45-degree field of view: 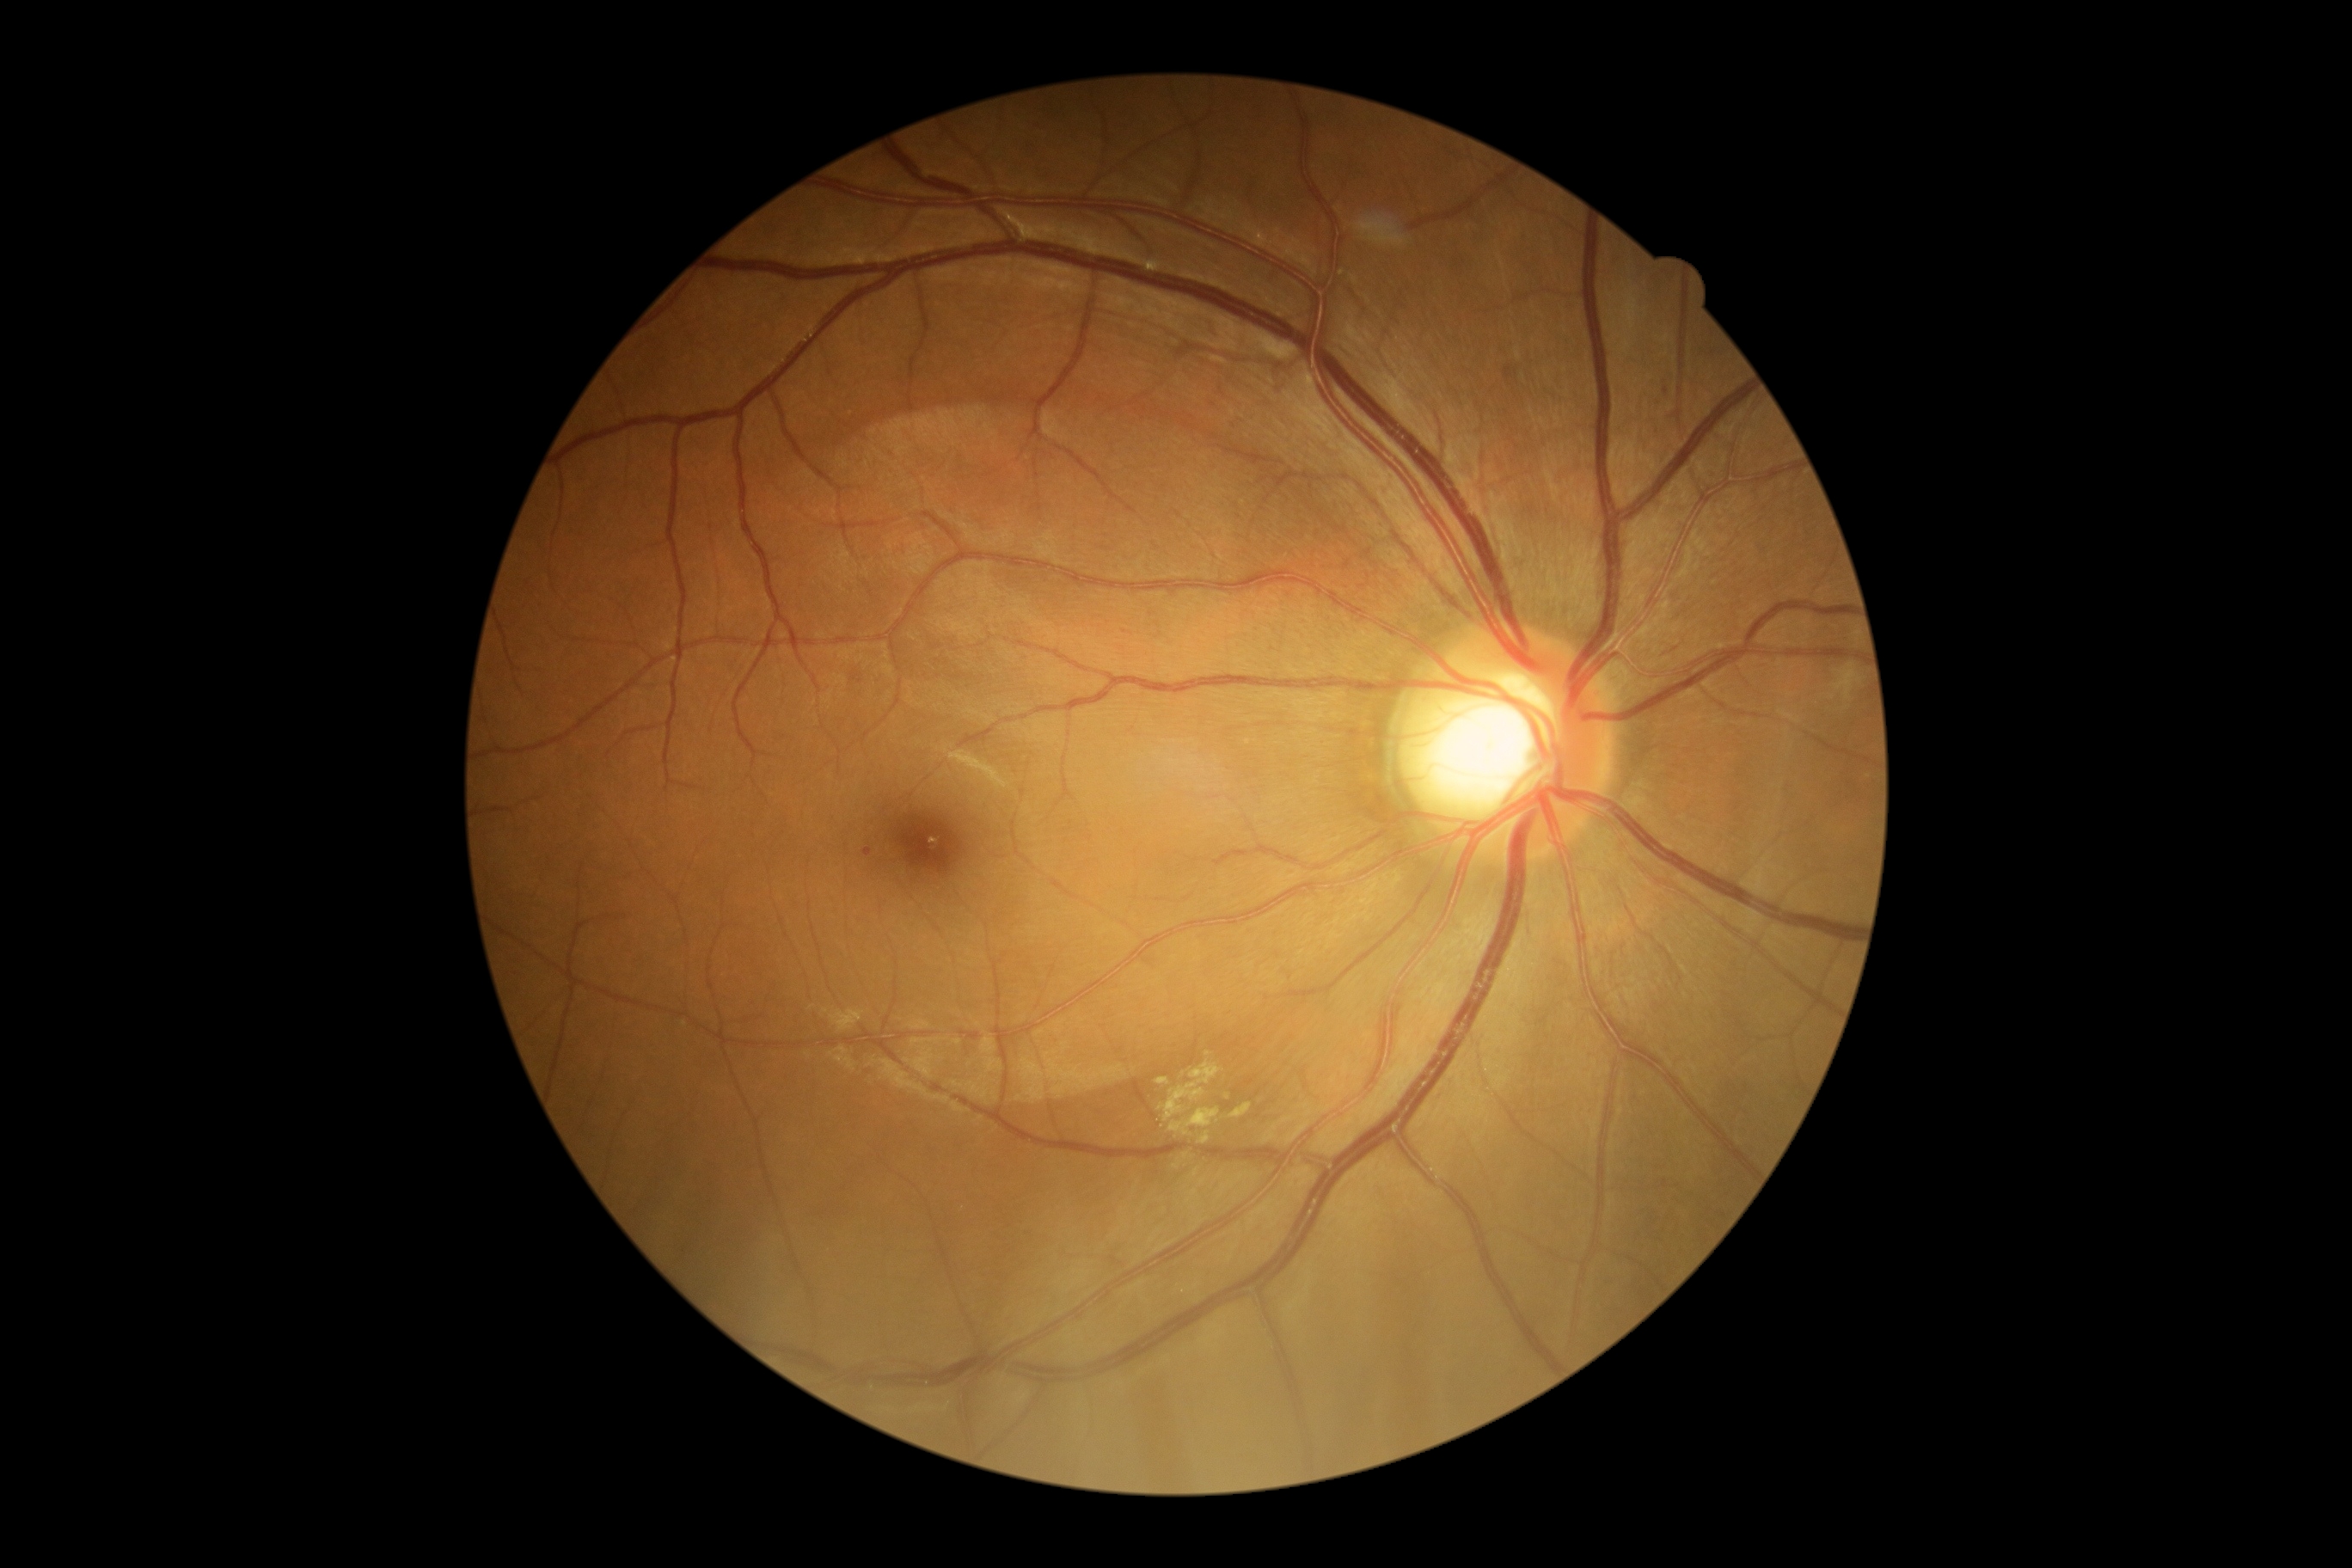 The retinopathy is classified as non-proliferative diabetic retinopathy.
DR stage is grade 2.